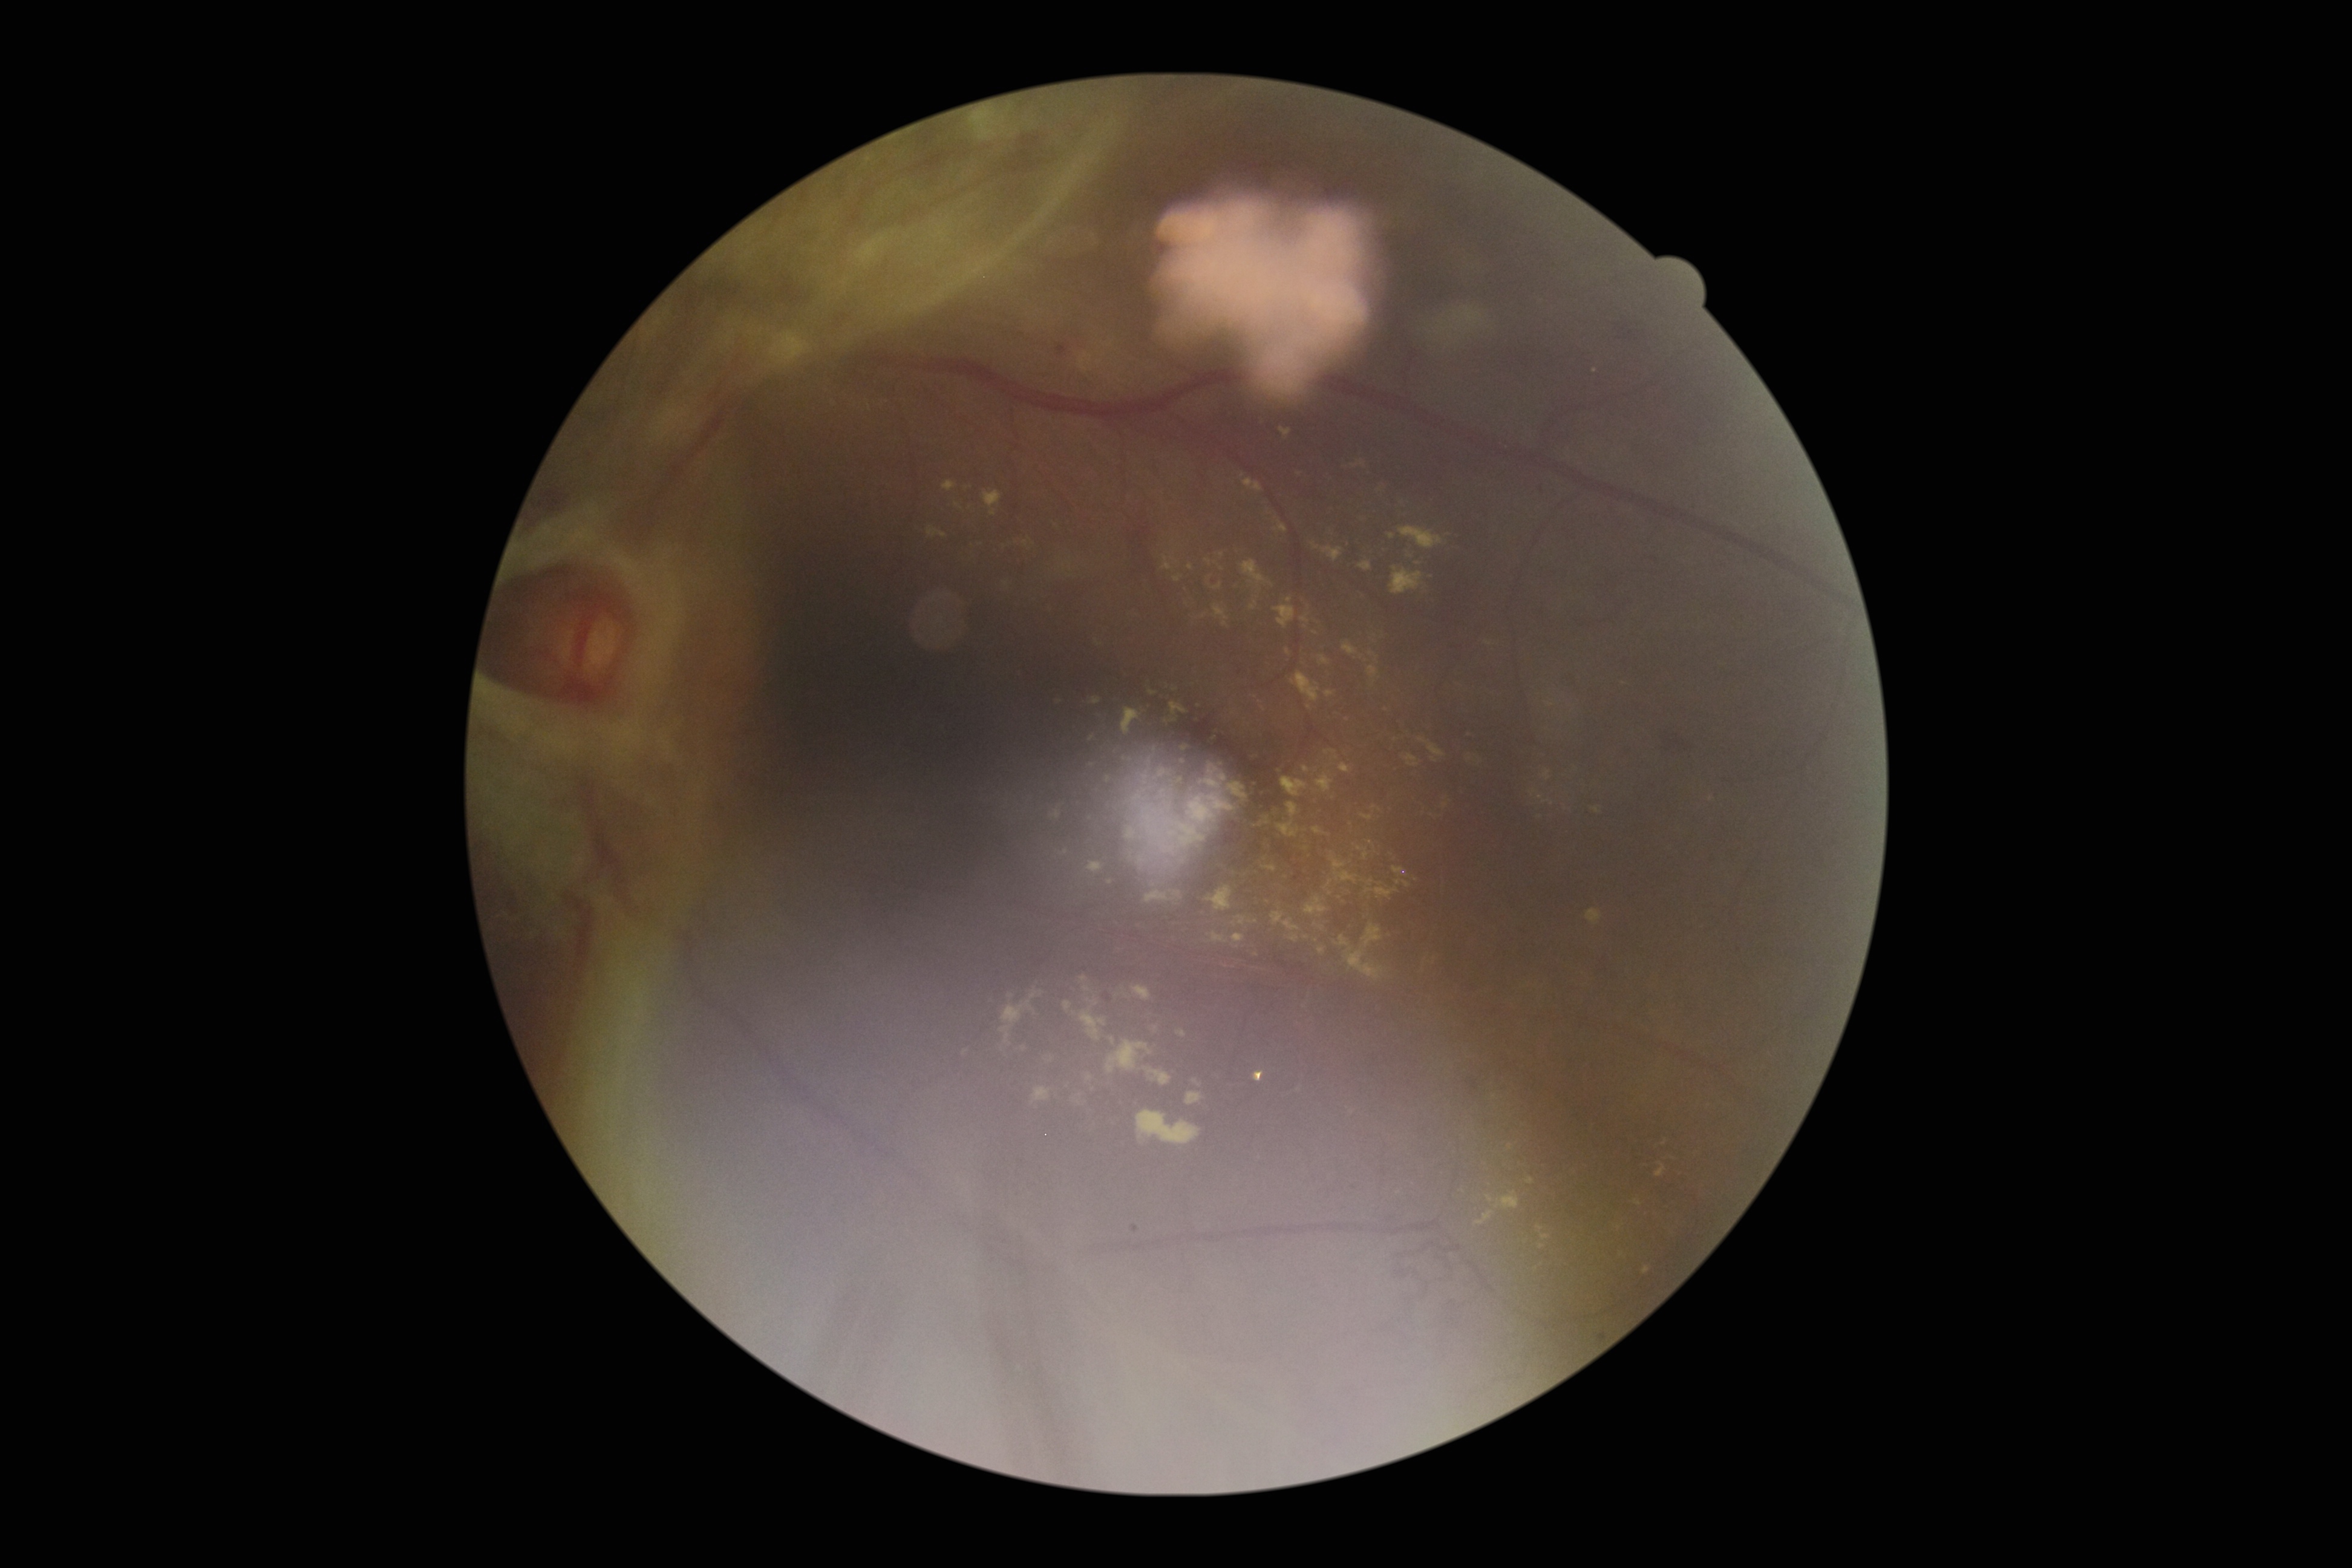
{"partial": true, "dr_grade": 4, "dr_grade_name": "PDR", "lesions": {"ex": [[927, 527, 947, 538], [1178, 746, 1194, 766], [1299, 848, 1307, 862], [1129, 787, 1146, 803], [1048, 799, 1064, 822], [1121, 706, 1139, 737], [1187, 564, 1194, 572], [1085, 861, 1103, 869], [1162, 556, 1174, 572], [1156, 780, 1181, 808], [1546, 702, 1555, 708], [1087, 760, 1098, 769], [1283, 675, 1317, 712], [1352, 460, 1365, 469], [1328, 855, 1348, 875]], "ex_small_approx": [[1209, 562], [1391, 536]]}}